1932x1932px, CFP.
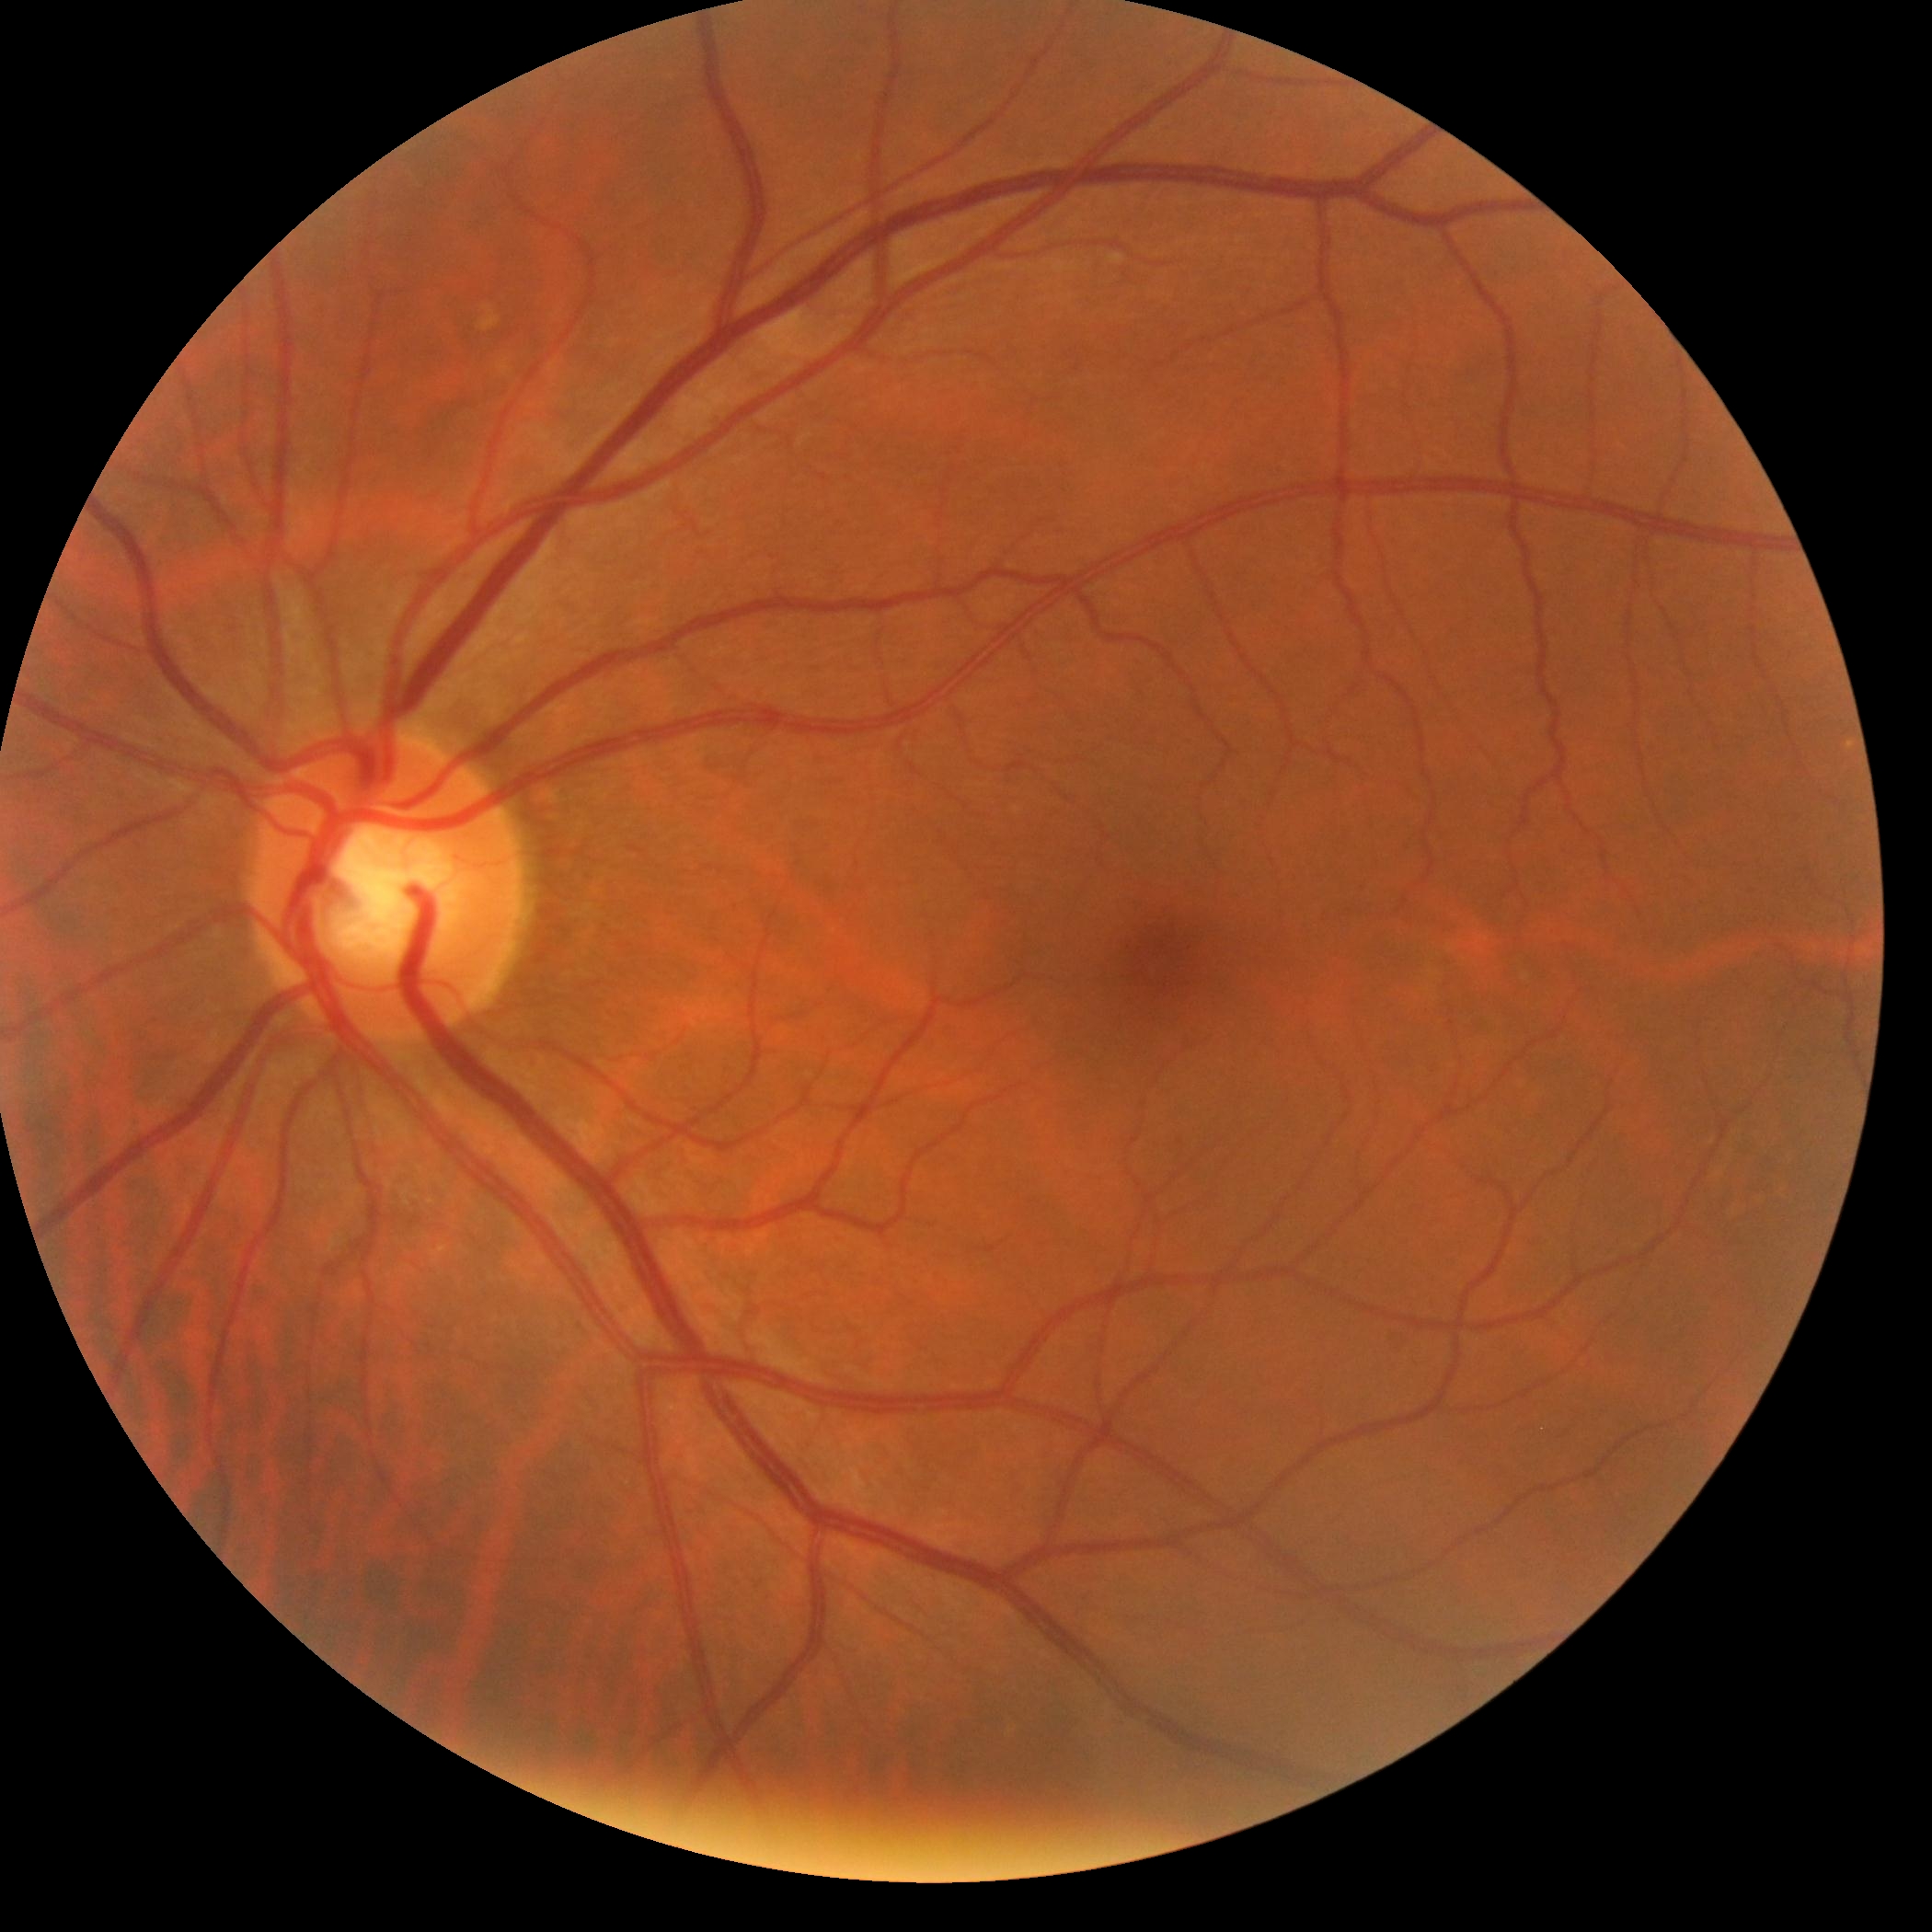

DR impression = negative for DR; DR stage = grade 0.